Color fundus photograph
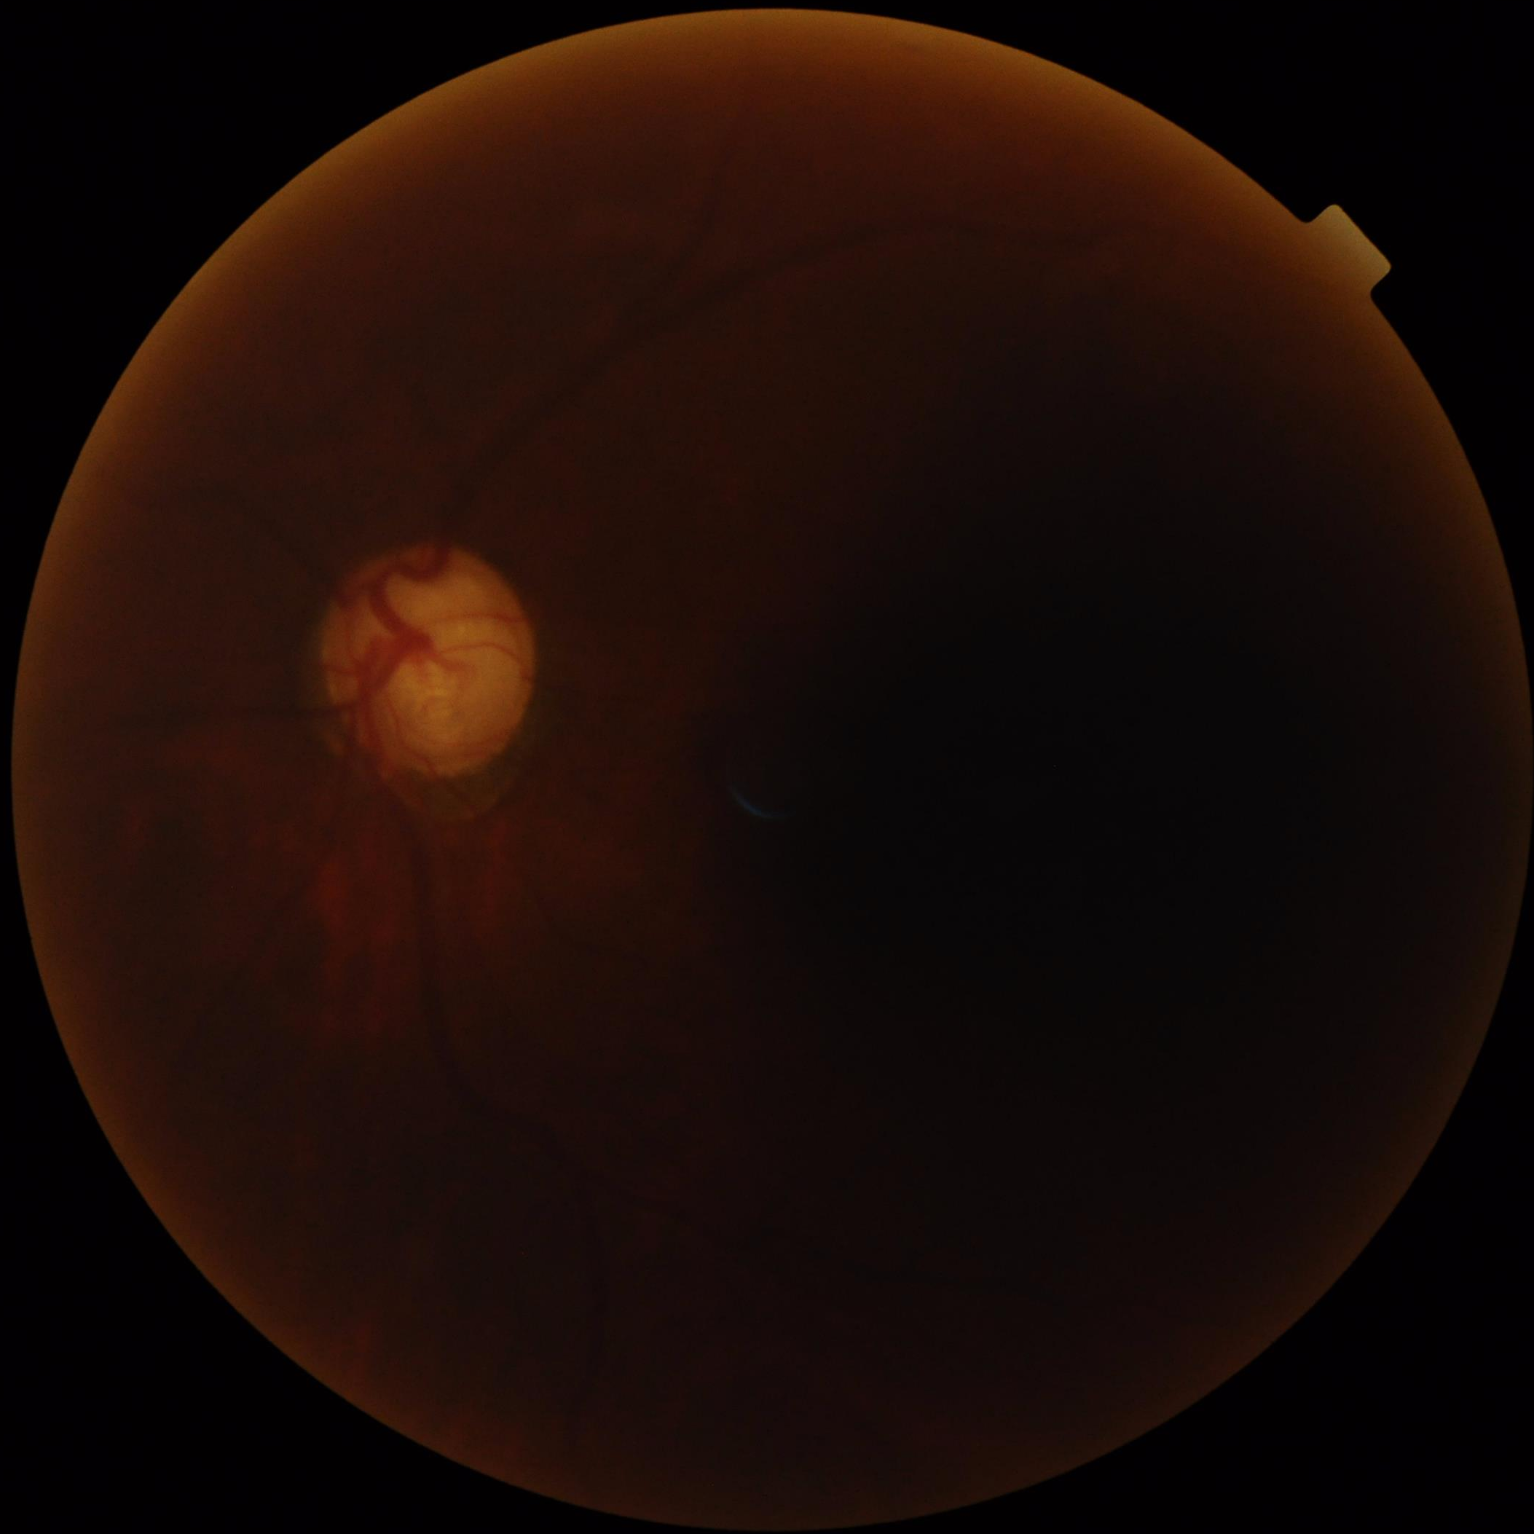
Contrast = low | Overall quality = low | Illumination = uneven | Sharpness = blurry.